Camera: NIDEK AFC-230; 848 by 848 pixels; FOV: 45 degrees
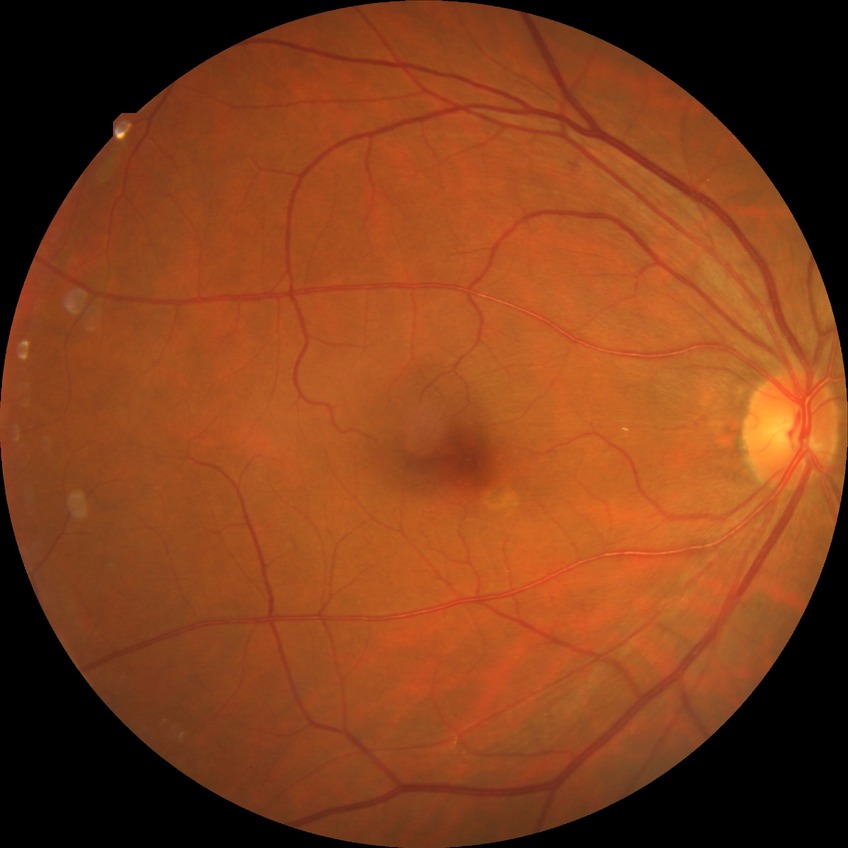

DR stage is NDR.